Nonmydriatic fundus photograph, 45-degree field of view: 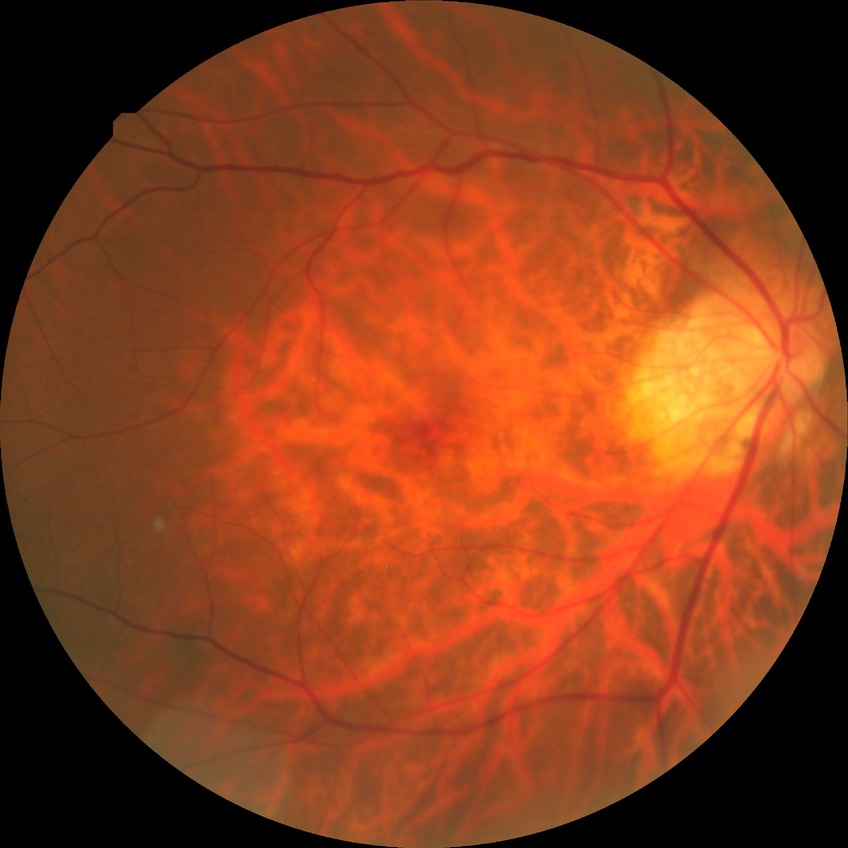
Davis DR grade: NDR.